FOV: 45 degrees · retinal fundus photograph · 2352x1568: 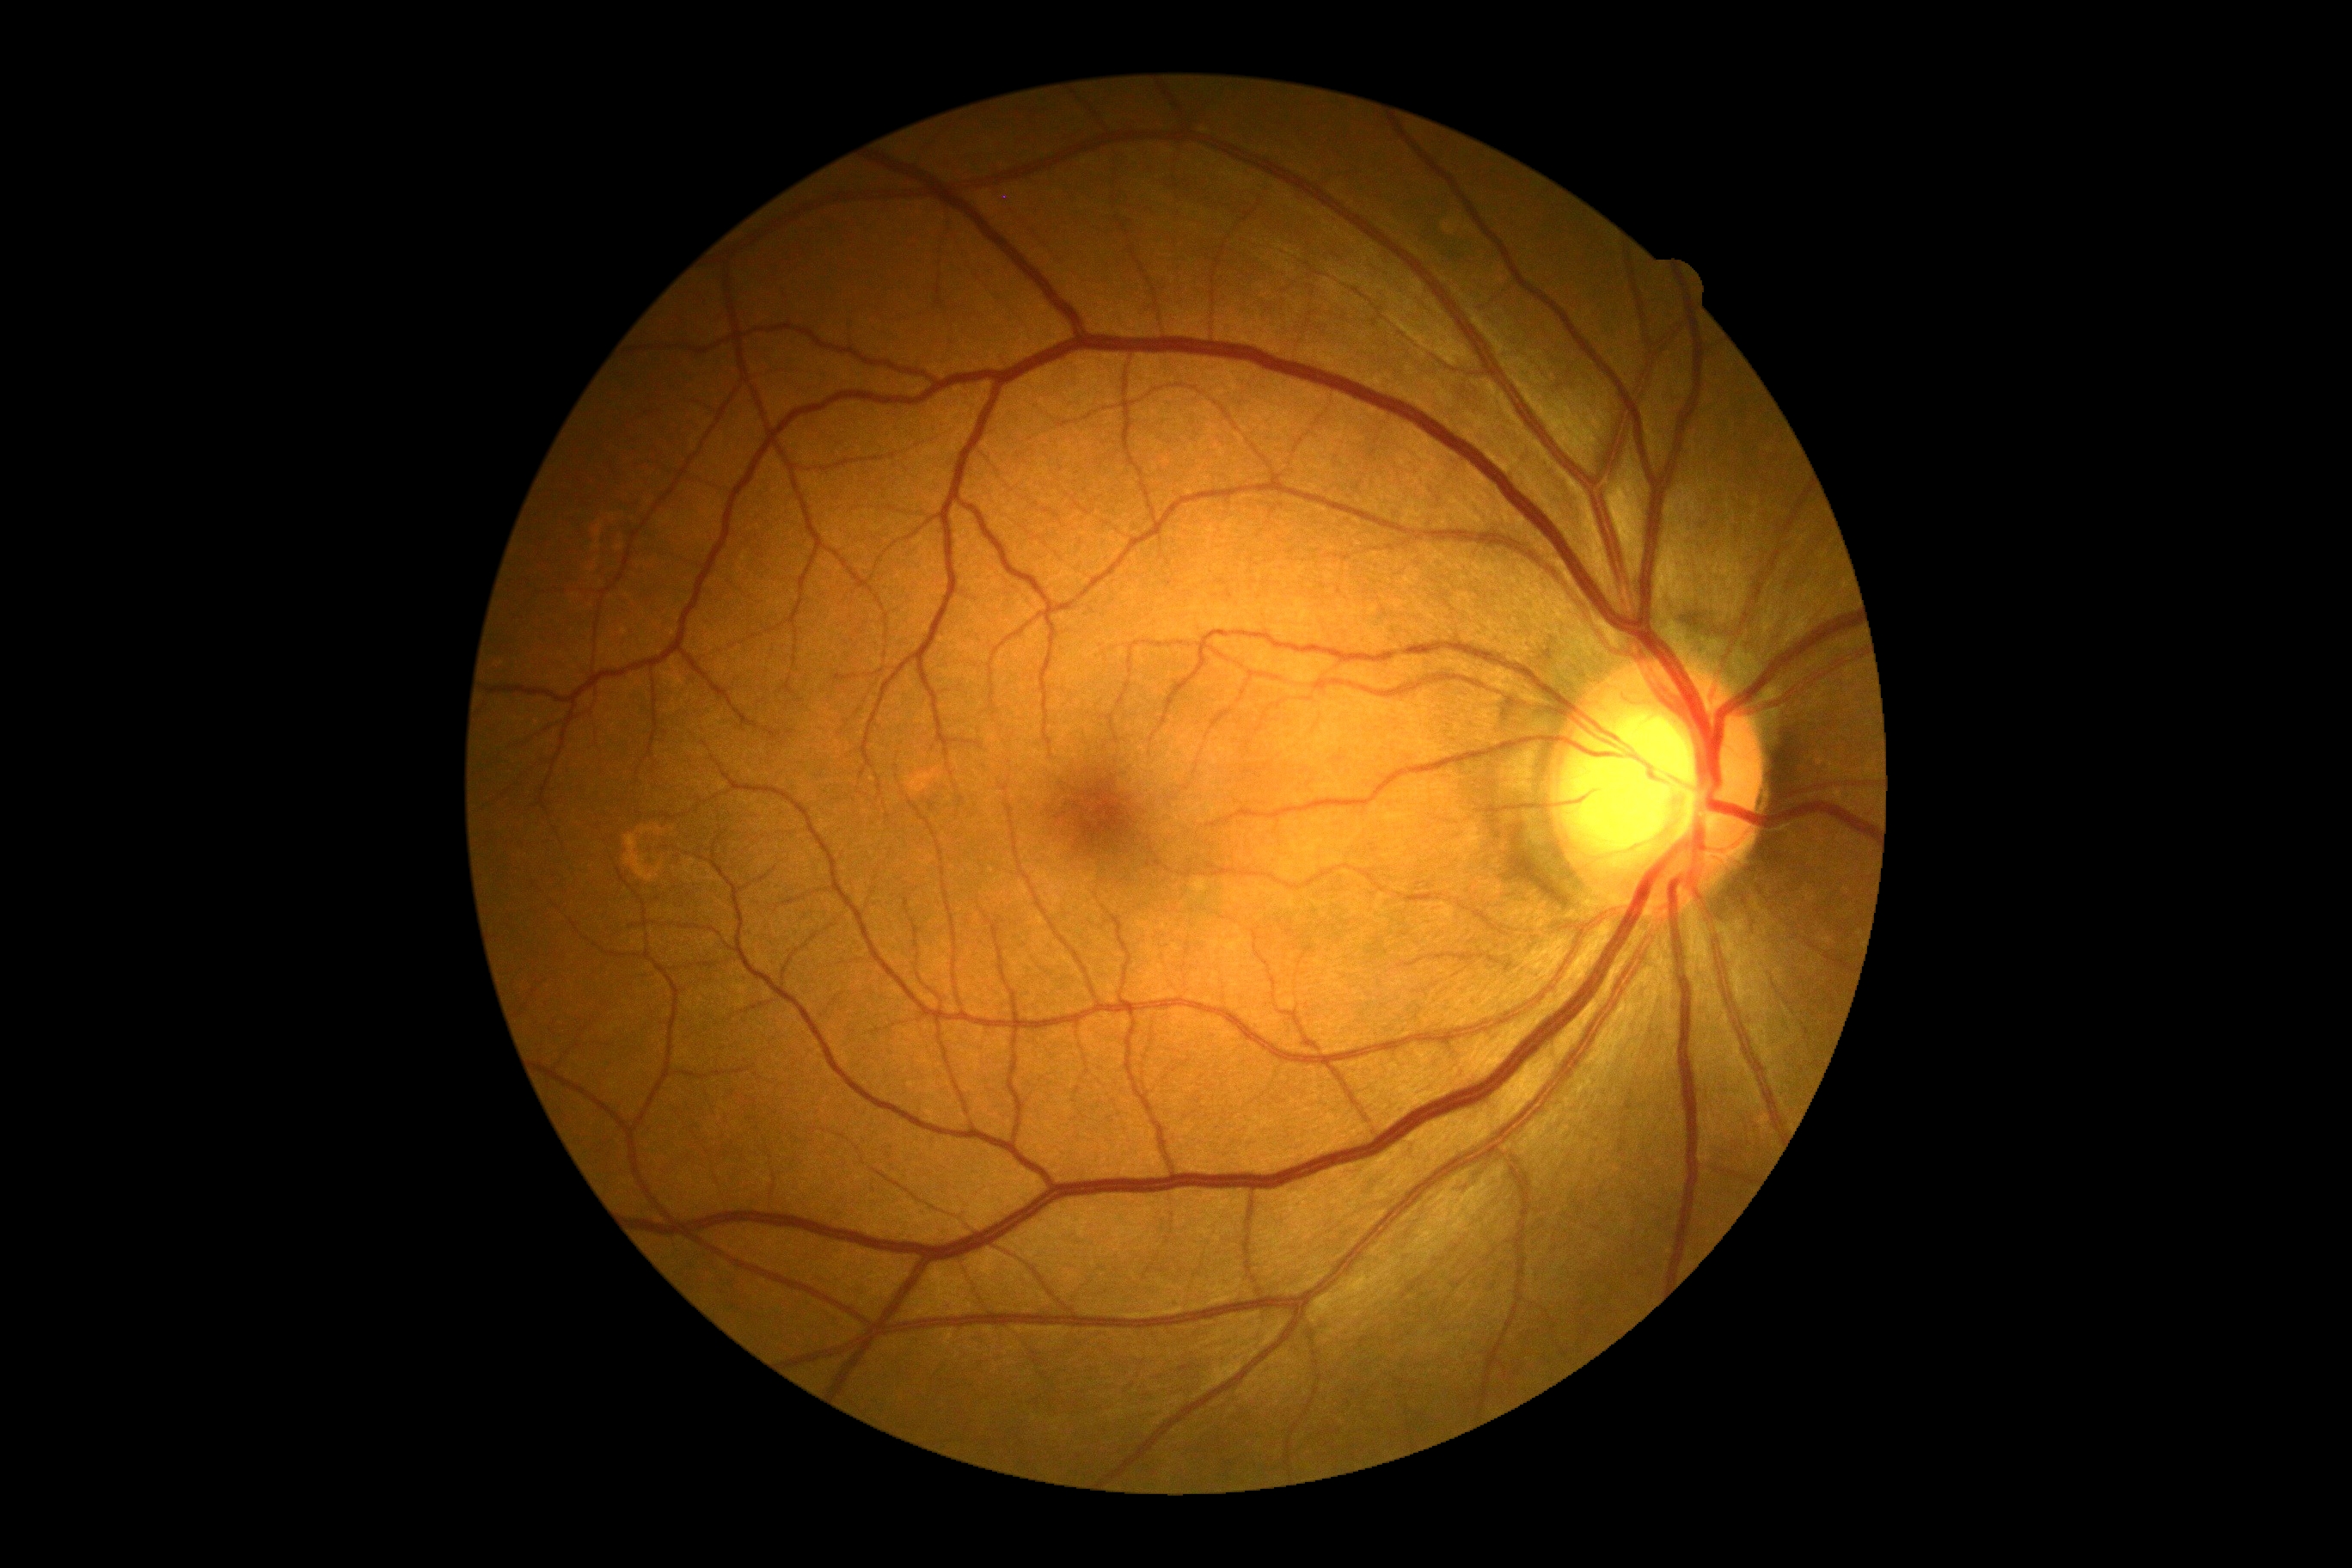

No DR findings.
DR grade: 0 (no apparent retinopathy).